Camera: NIDEK AFC-230; graded on the modified Davis scale; posterior pole color fundus photograph; nonmydriatic fundus photograph; 45° field of view.
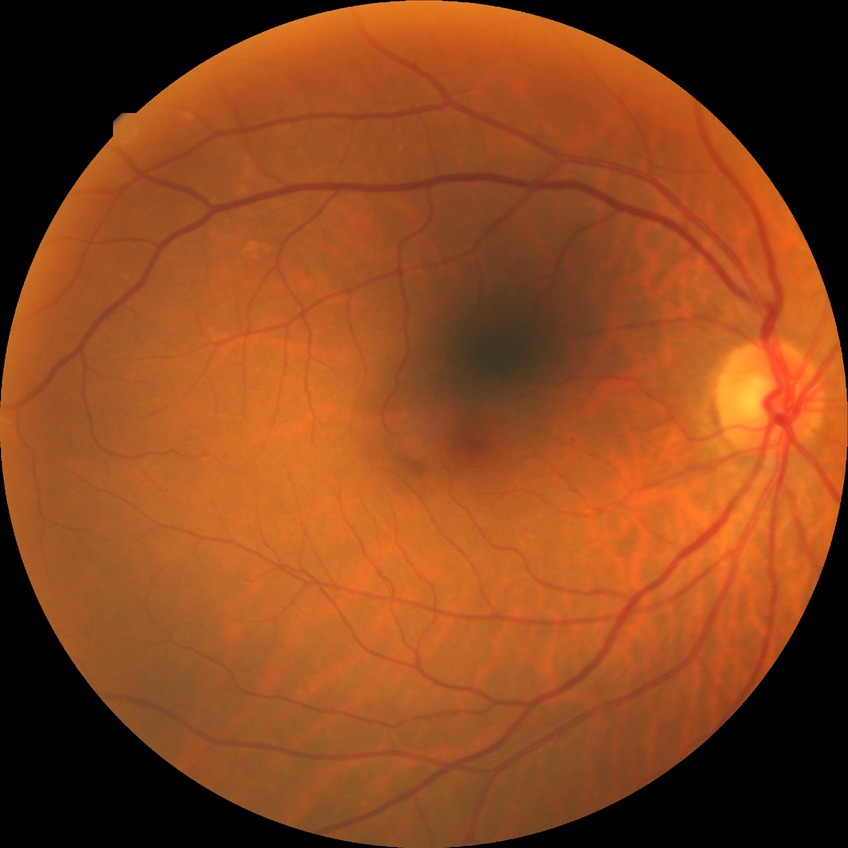
Diabetic retinopathy (DR) is NDR (no diabetic retinopathy).